Modified Davis grading. 45-degree field of view. Color fundus photograph. Nonmydriatic fundus photograph. 848x848px:
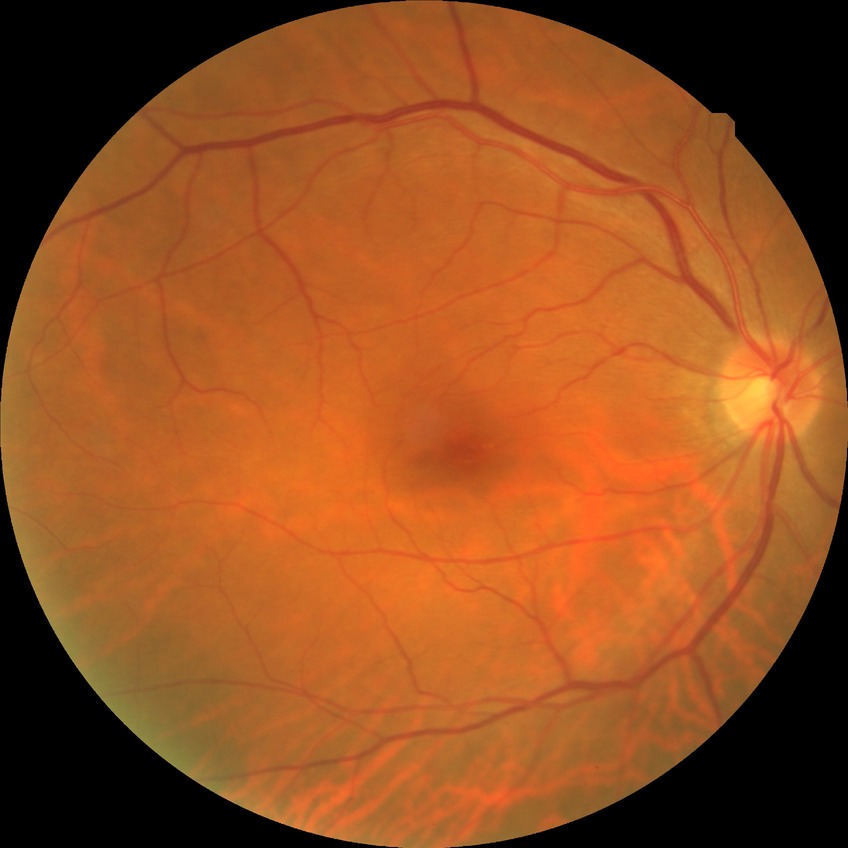 Modified Davis grading: no diabetic retinopathy.